Wide-field fundus photograph from neonatal ROP screening
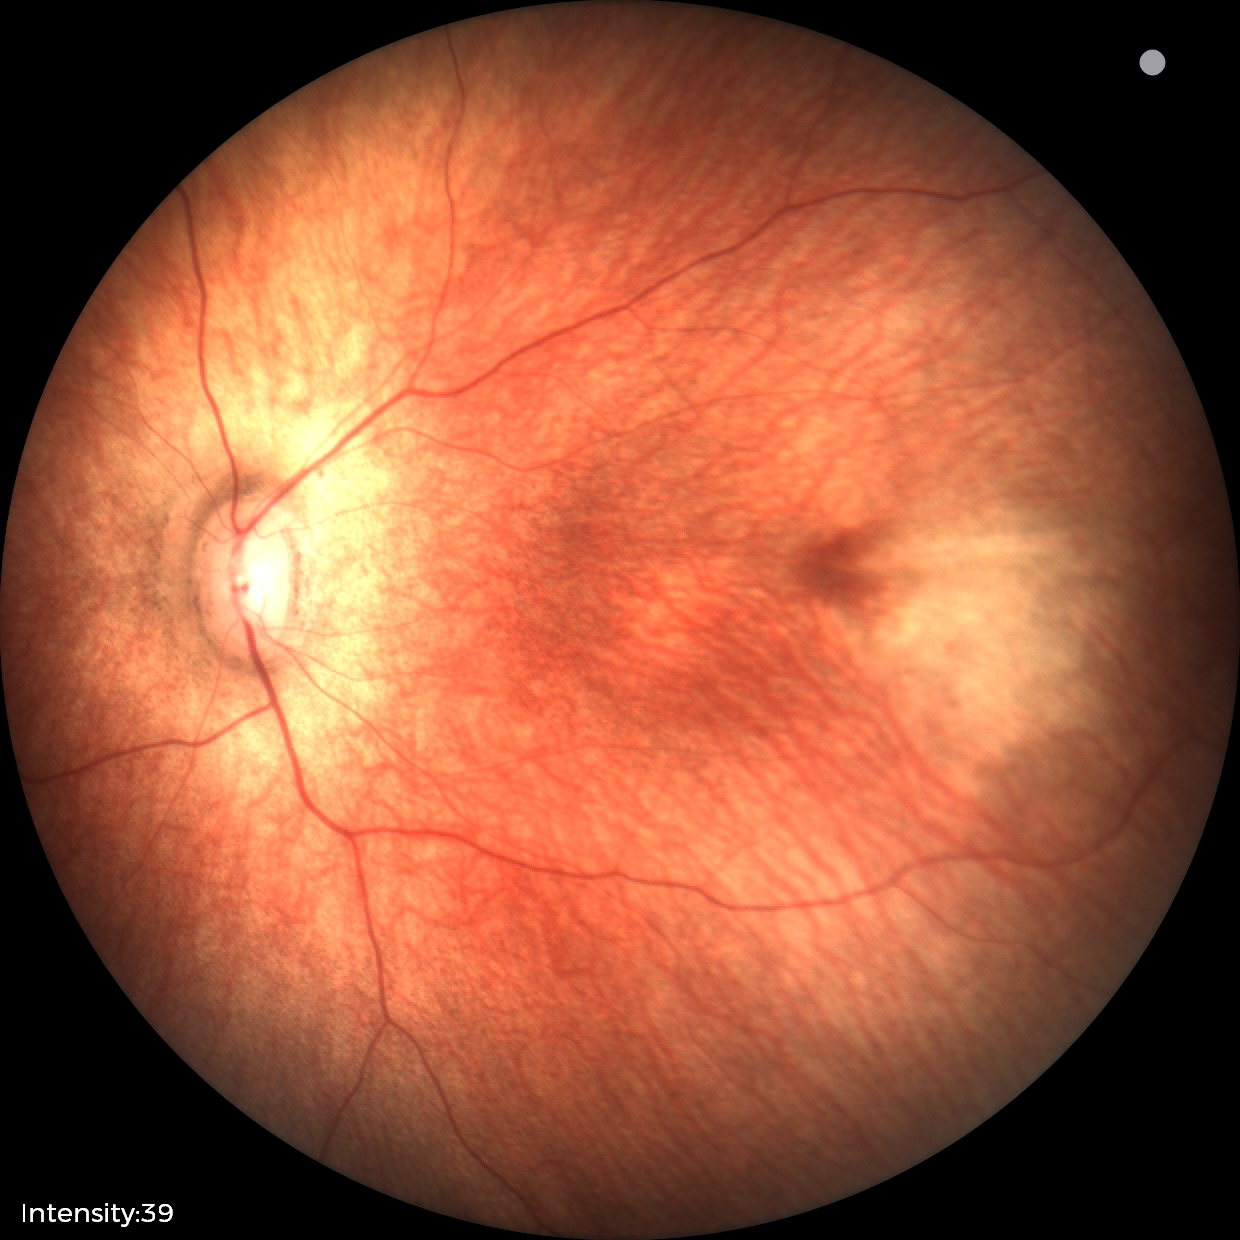

Q: What is the screening diagnosis?
A: no abnormal retinal findings